45° field of view, 2346 by 1568 pixels, fundus photo — 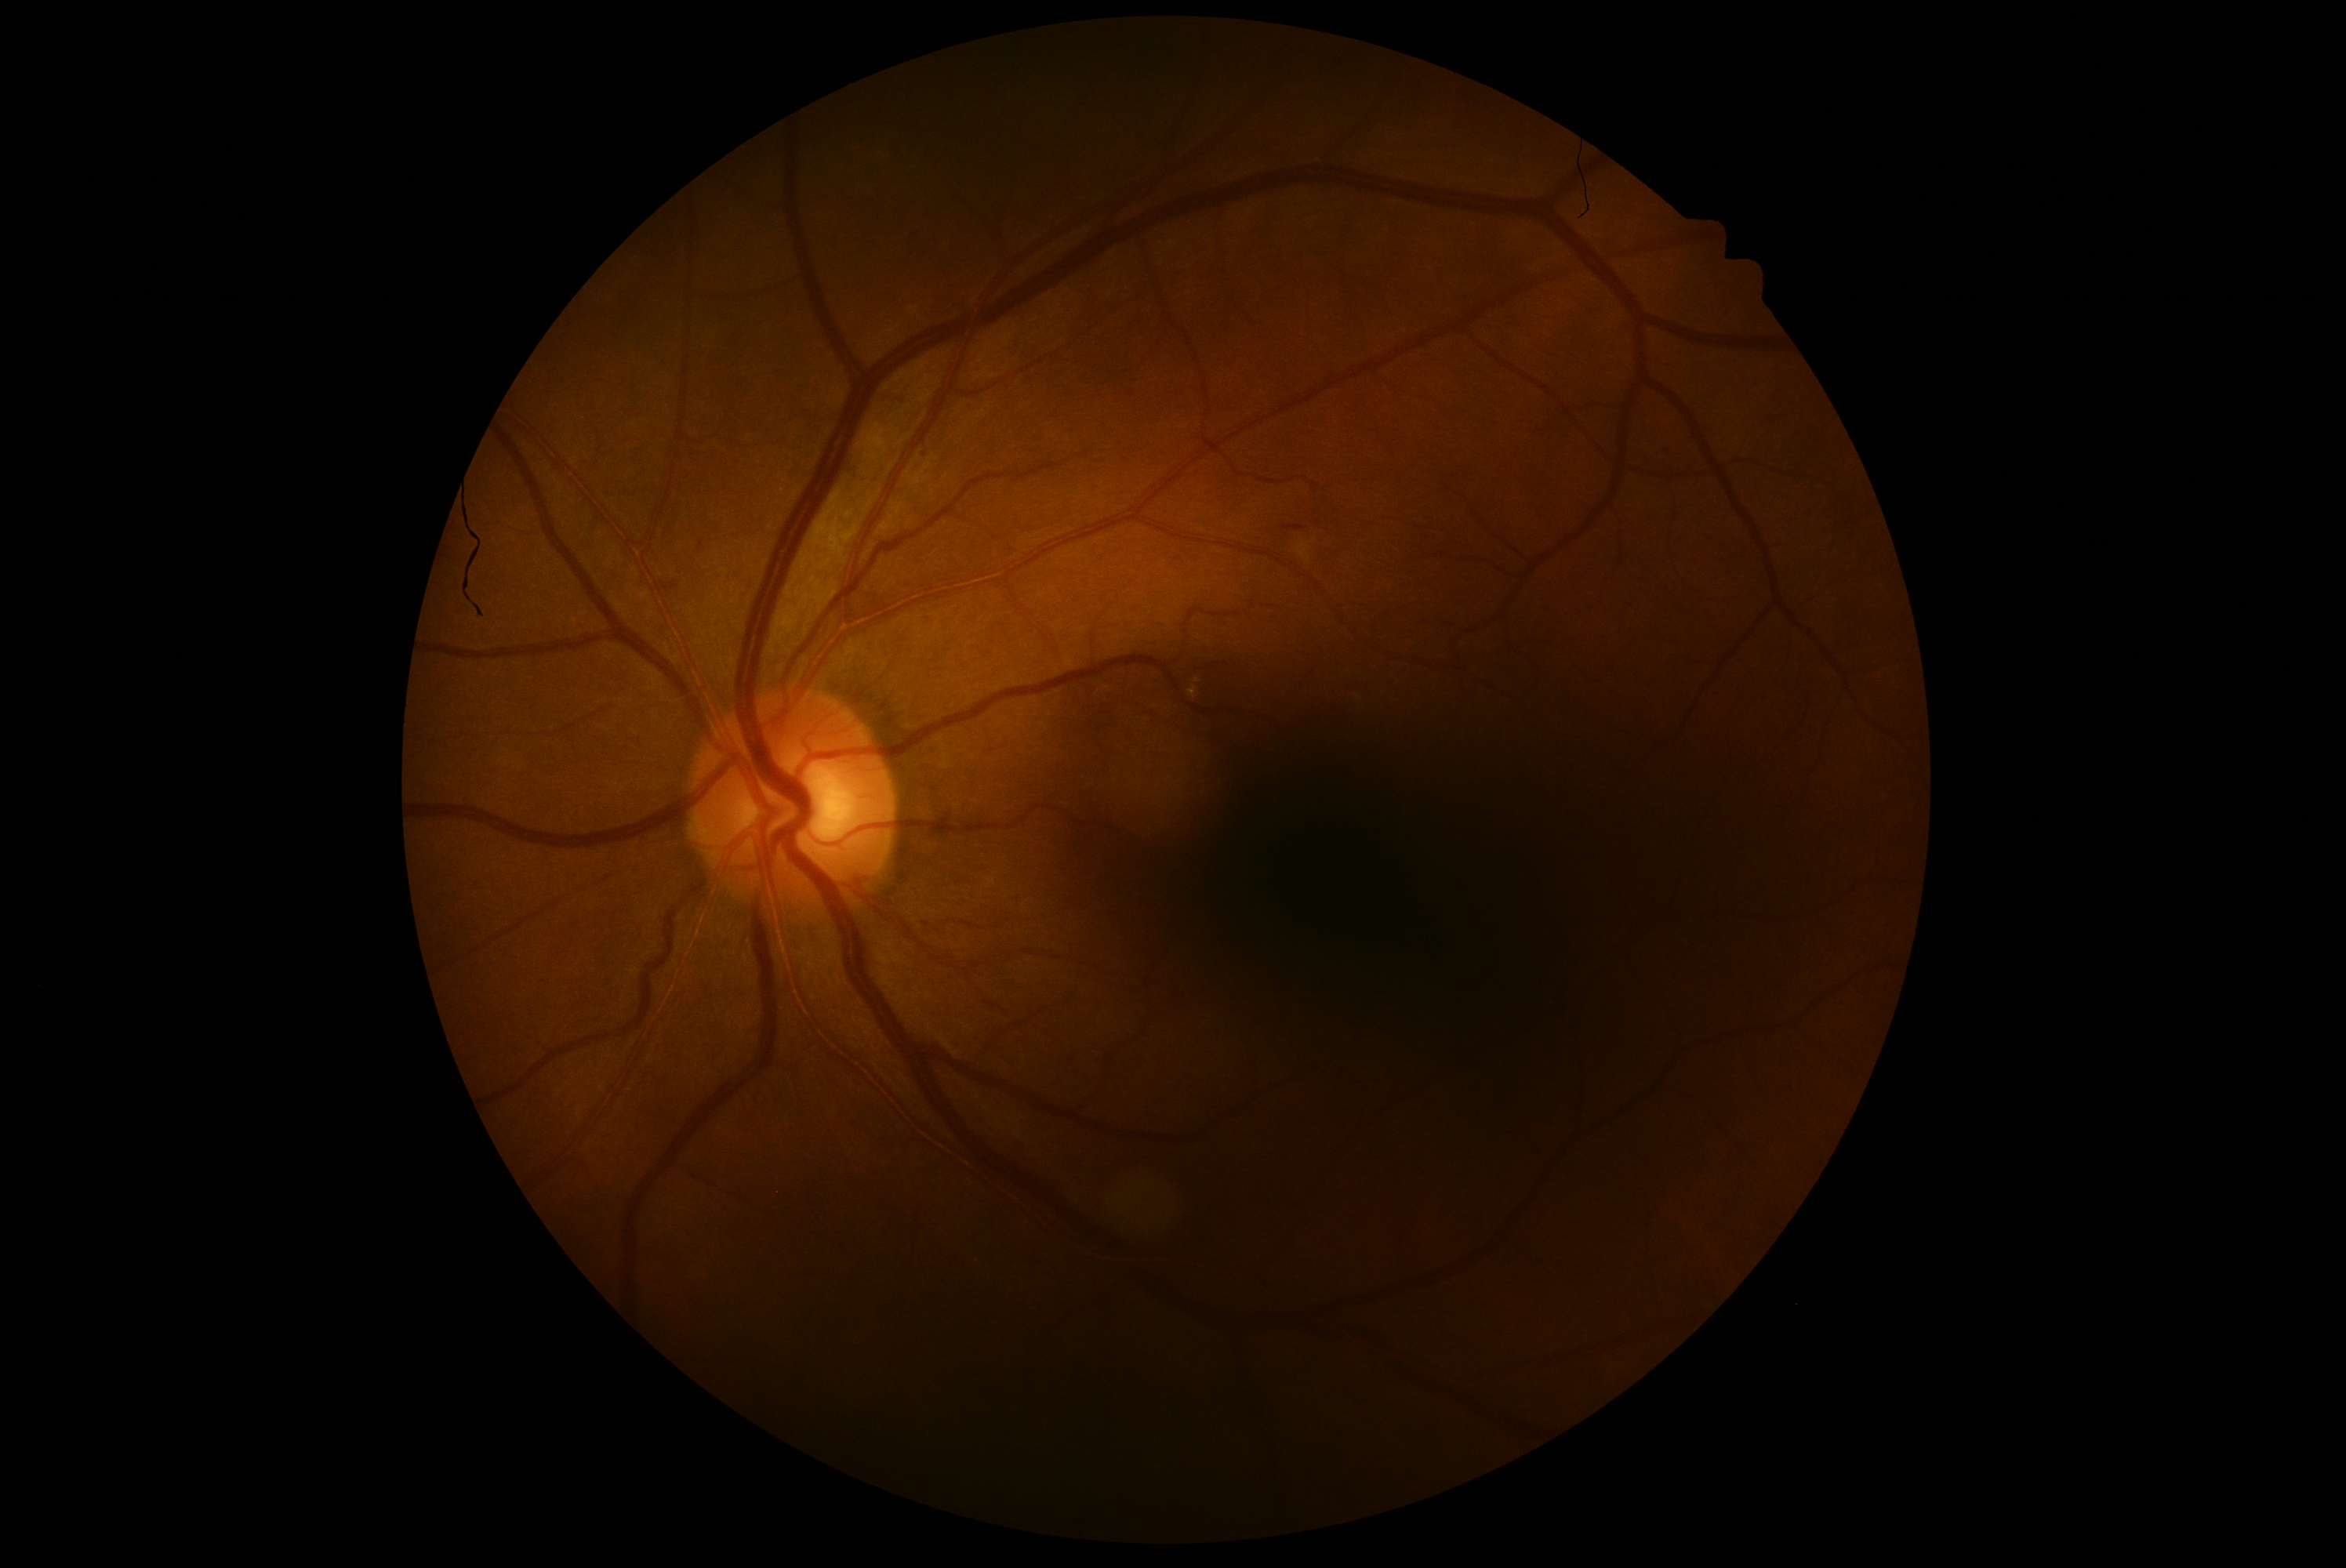
diabetic retinopathy (DR) = grade 2 (moderate NPDR); DR class = non-proliferative diabetic retinopathy.